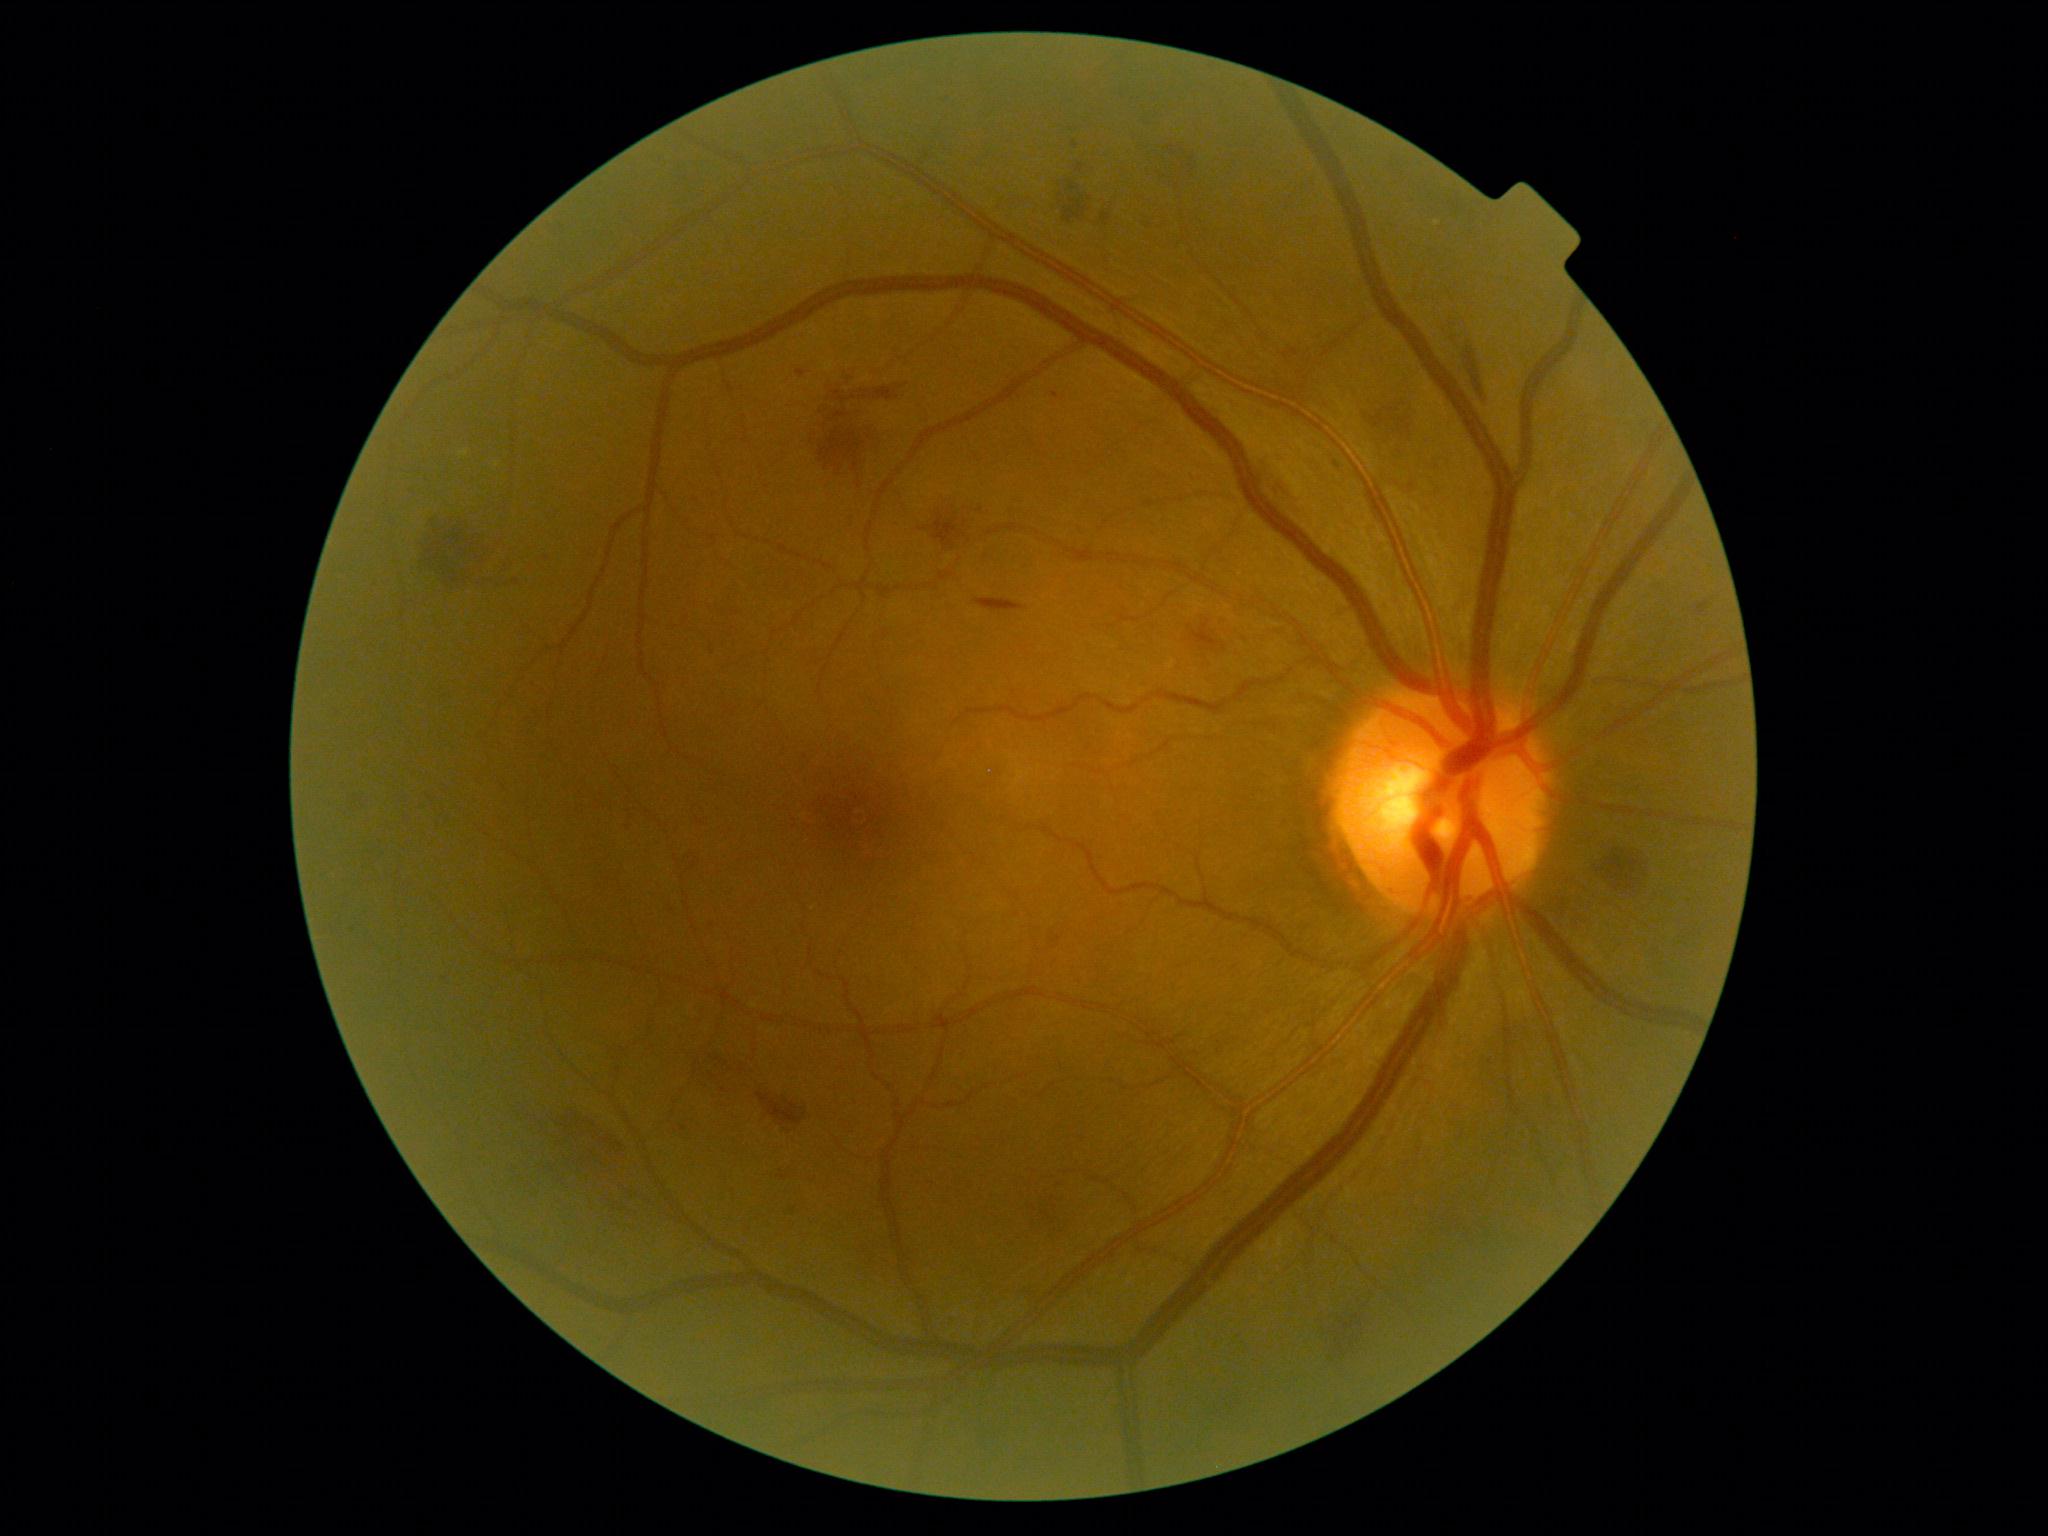

DR is grade 2 — more than just microaneurysms but less than severe NPDR
A subset of detected lesions:
HEs (partial) = (x1=352, y1=796, x2=368, y2=815) | (x1=1052, y1=936, x2=1062, y2=944) | (x1=698, y1=1050, x2=746, y2=1082) | (x1=1102, y1=212, x2=1112, y2=226) | (x1=1464, y1=347, x2=1484, y2=399) | (x1=819, y1=417, x2=866, y2=472) | (x1=1033, y1=1192, x2=1073, y2=1241) | (x1=976, y1=599, x2=1027, y2=612) | (x1=933, y1=513, x2=967, y2=548) | (x1=1695, y1=601, x2=1710, y2=617) | (x1=1372, y1=407, x2=1417, y2=434) | (x1=418, y1=515, x2=492, y2=579)
HEs (small, approximate centers) near [694,865]
MAs = (x1=1072, y1=141, x2=1079, y2=150) | (x1=1333, y1=462, x2=1341, y2=469) | (x1=796, y1=370, x2=808, y2=378) | (x1=680, y1=1125, x2=688, y2=1132)
MAs (small, approximate centers) near [1056,396] | [629,827]
EXs = none identified
SEs = none identified